Retinal fundus photograph.
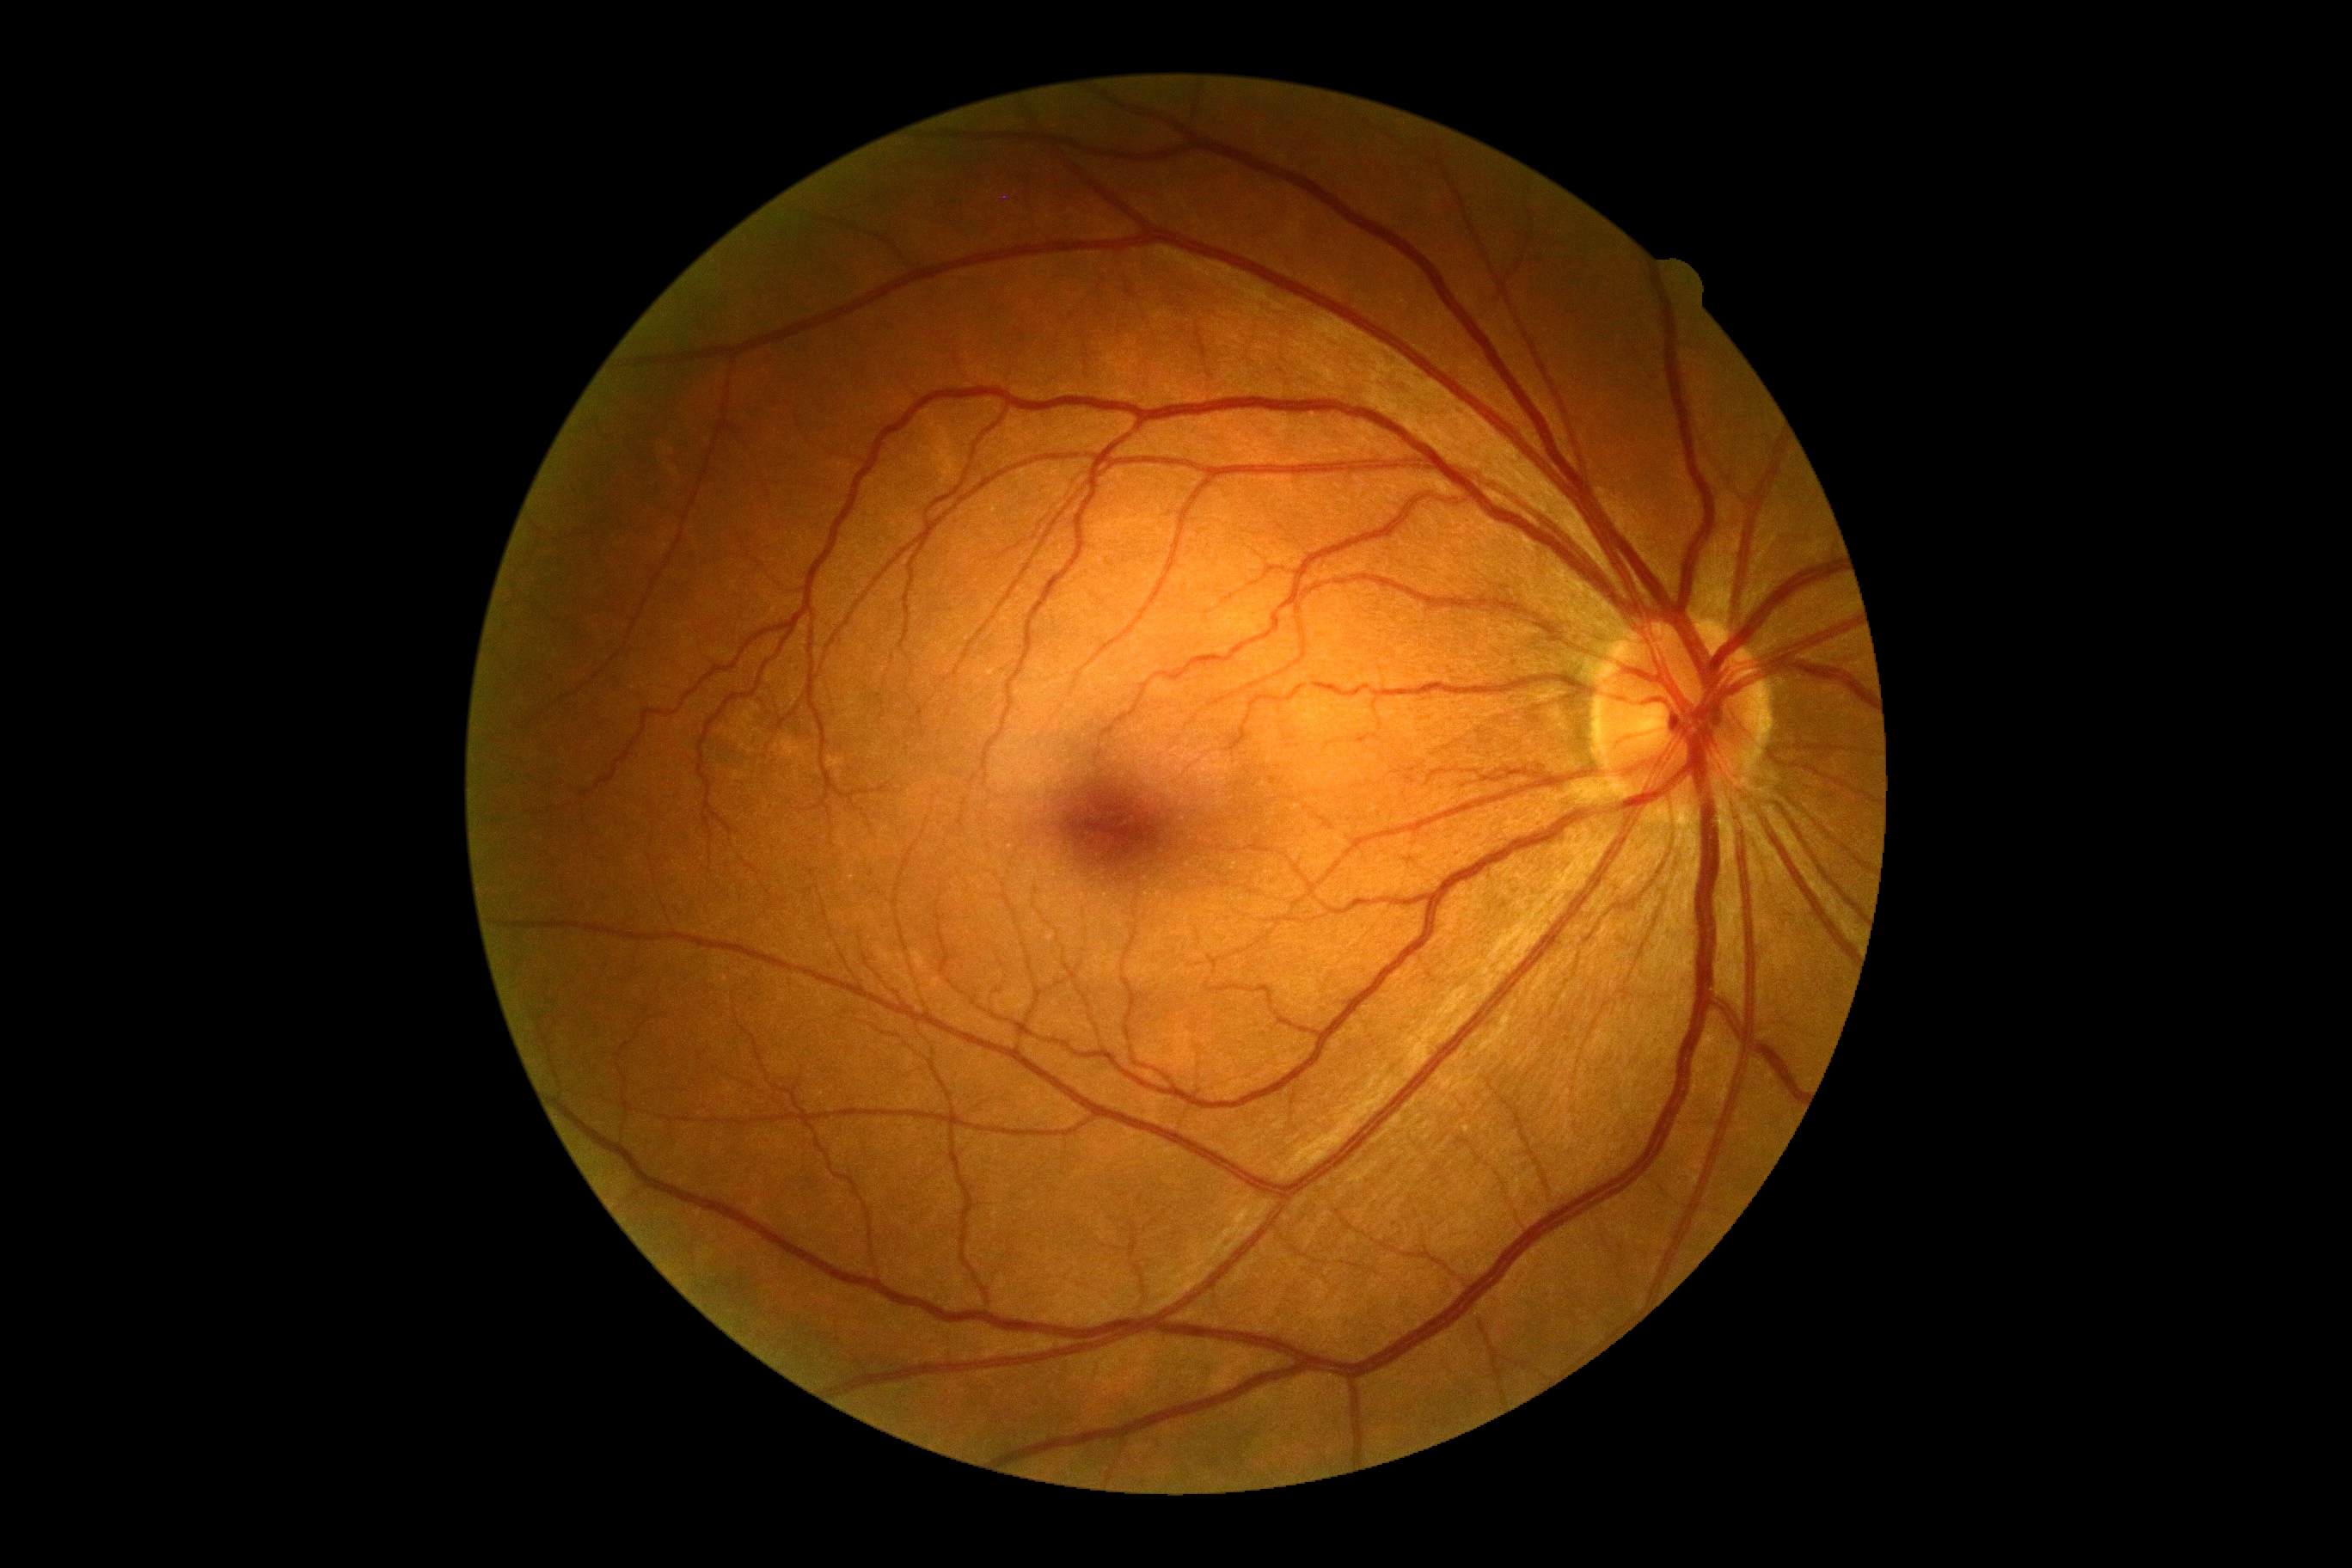
Diabetic retinopathy (DR): no apparent retinopathy (grade 0) — no visible signs of diabetic retinopathy.